Image size 848x848. Nonmydriatic fundus photograph
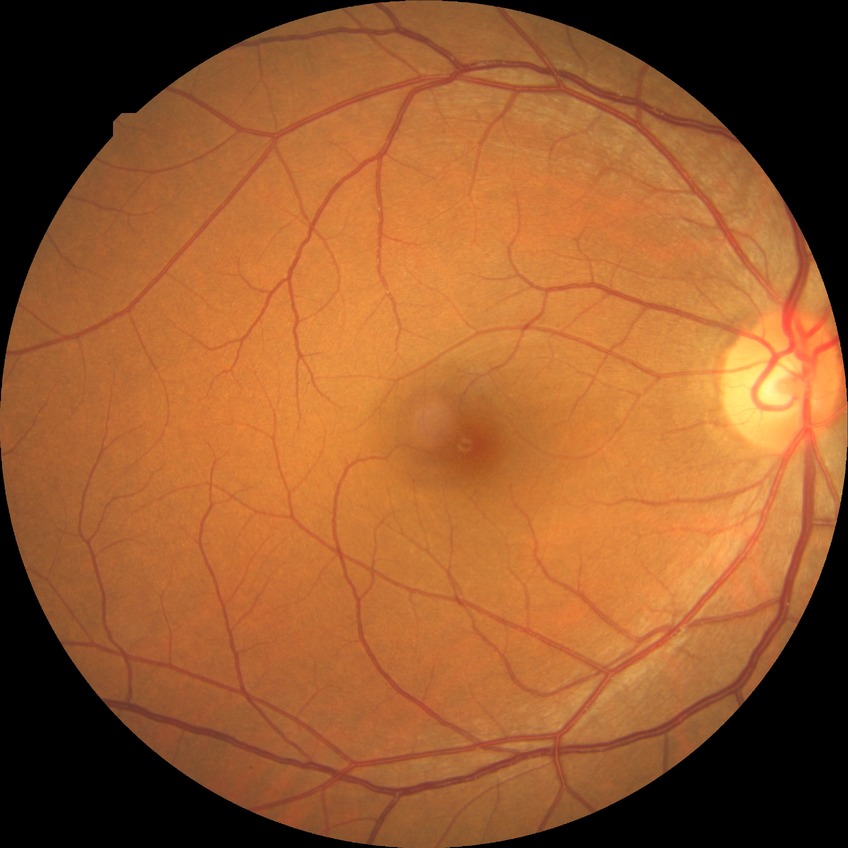 Davis grade is NDR.
No diabetic retinal disease findings.